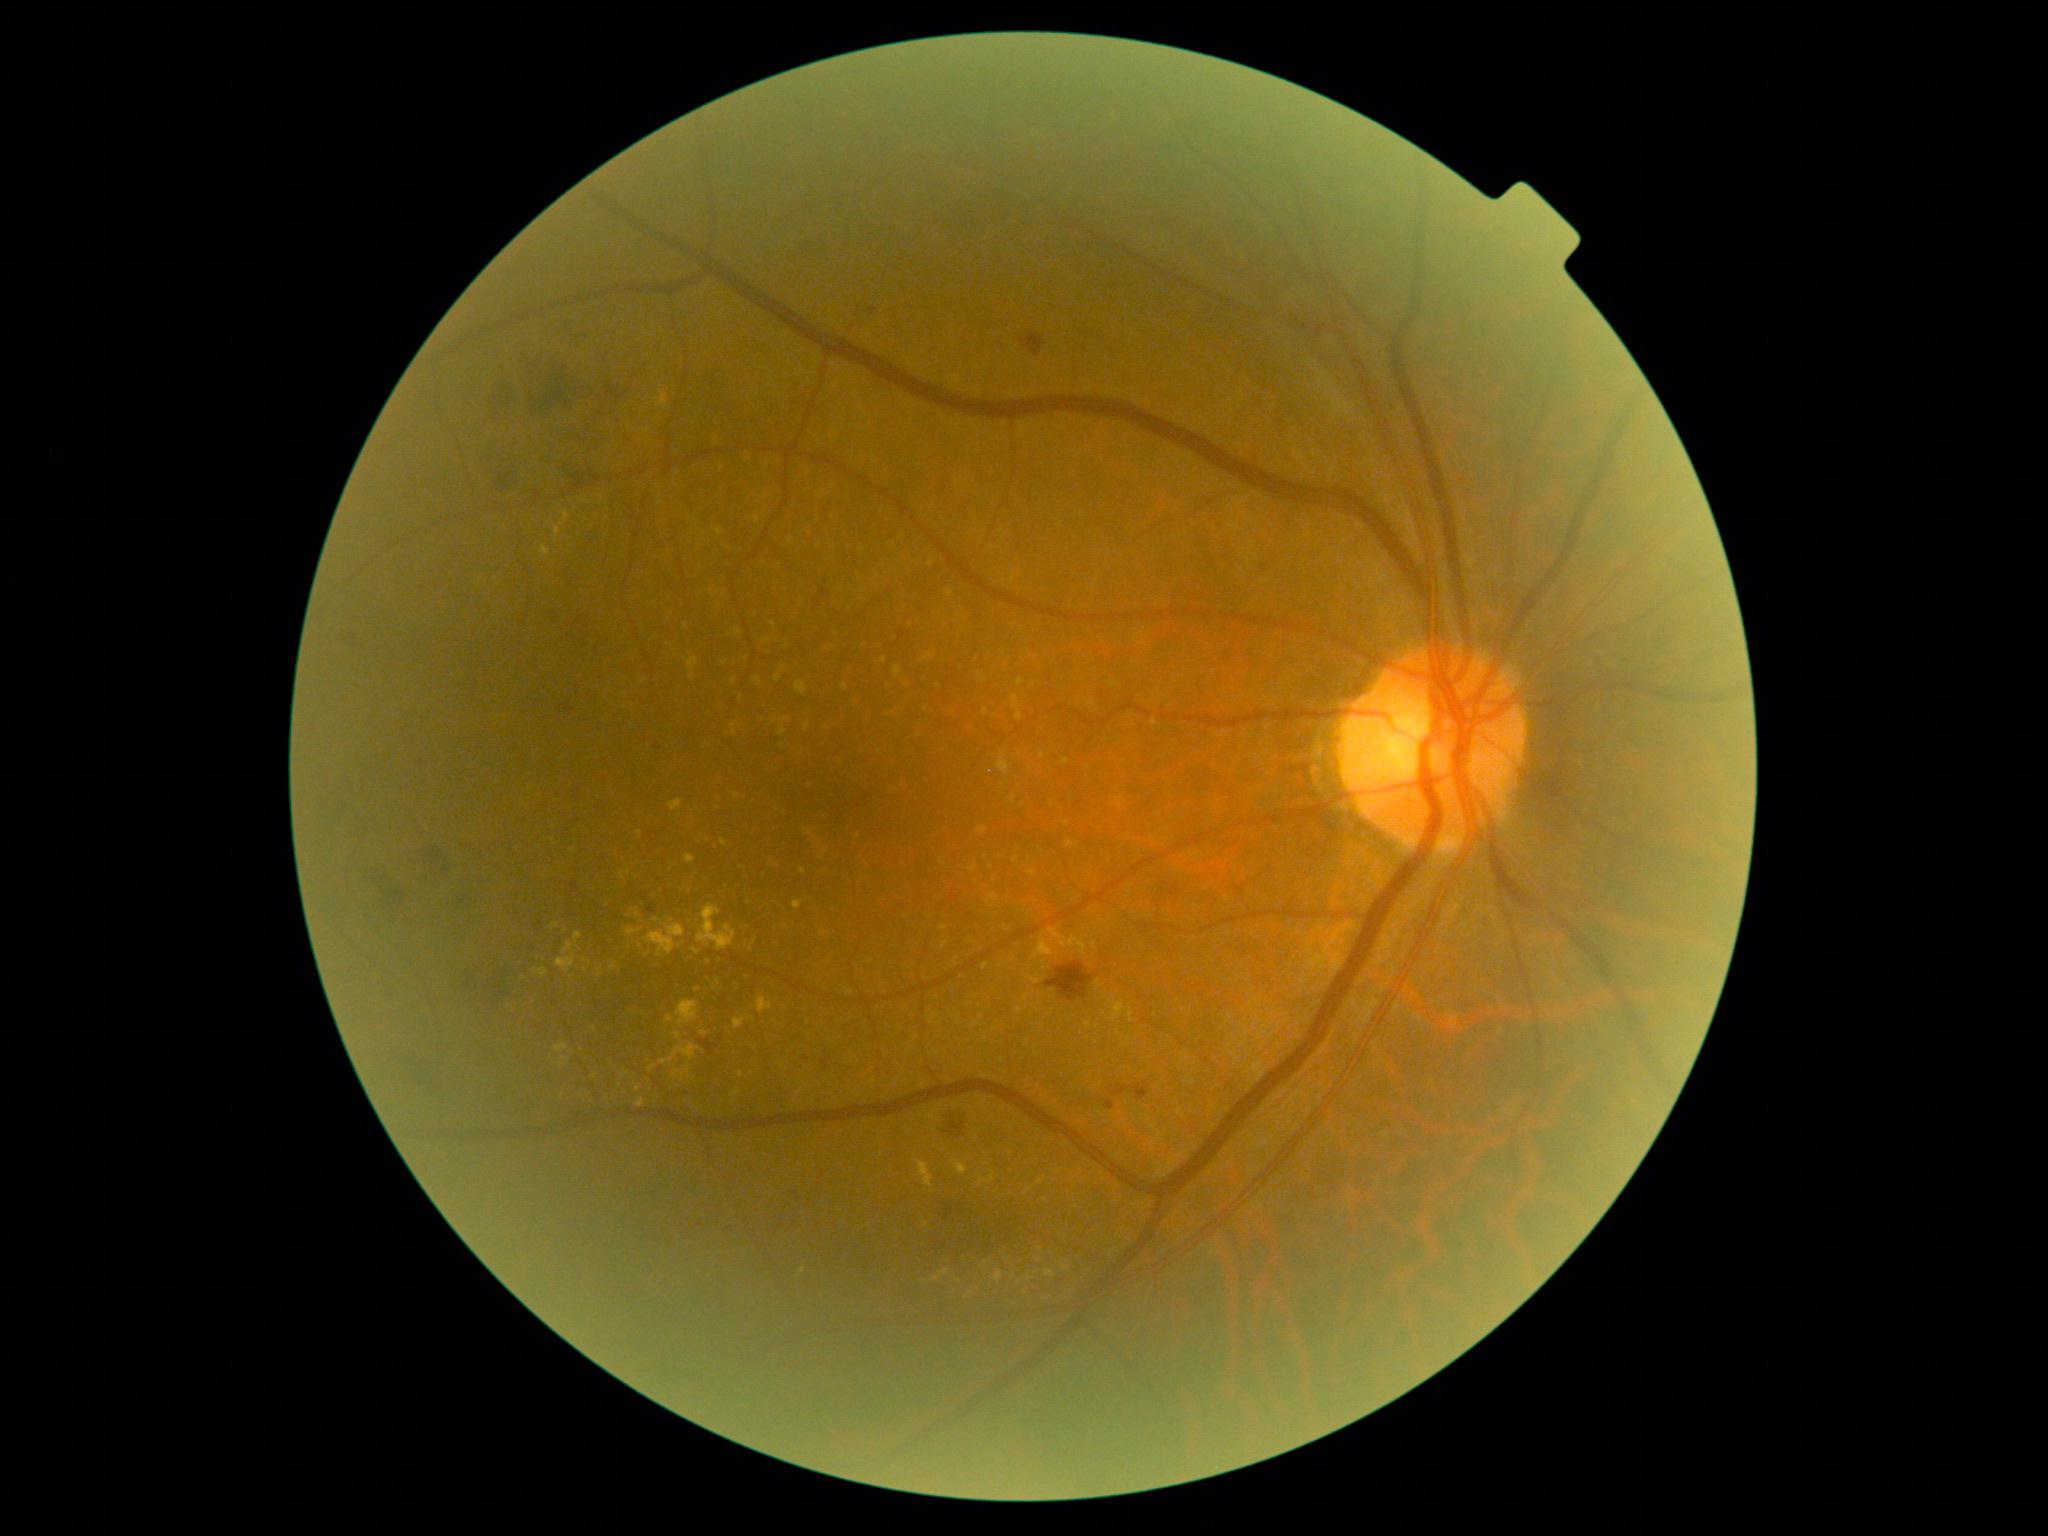
Diabetic retinopathy (DR) is moderate non-proliferative diabetic retinopathy (grade 2)
A subset of detected lesions:
• hard exudates (EXs) (more not shown): BBox(561, 511, 571, 525) | BBox(645, 924, 685, 956) | BBox(673, 1070, 680, 1078) | BBox(693, 948, 701, 956) | BBox(621, 869, 631, 878) | BBox(918, 1161, 934, 1188) | BBox(734, 1019, 746, 1029) | BBox(685, 1065, 691, 1073) | BBox(583, 960, 592, 964) | BBox(675, 1032, 683, 1043) | BBox(934, 1269, 950, 1281)
• EXs (small, approximate centers) near (709; 962) | (600; 969) | (653; 1068) | (698; 991) | (655; 920) | (640; 834) | (971; 1292)
• hemorrhages (HEs) (more not shown): BBox(655, 744, 662, 752) | BBox(365, 862, 417, 923) | BBox(529, 920, 563, 964) | BBox(562, 315, 595, 348) | BBox(700, 1040, 719, 1053) | BBox(553, 416, 604, 447) | BBox(388, 1046, 436, 1095) | BBox(1109, 1082, 1149, 1101) | BBox(645, 907, 655, 915) | BBox(945, 1115, 966, 1139) | BBox(1262, 564, 1269, 574) | BBox(1020, 334, 1046, 357) | BBox(795, 231, 828, 271) | BBox(479, 960, 513, 1010) | BBox(562, 611, 612, 661) | BBox(565, 703, 575, 714)